2089x1764px:
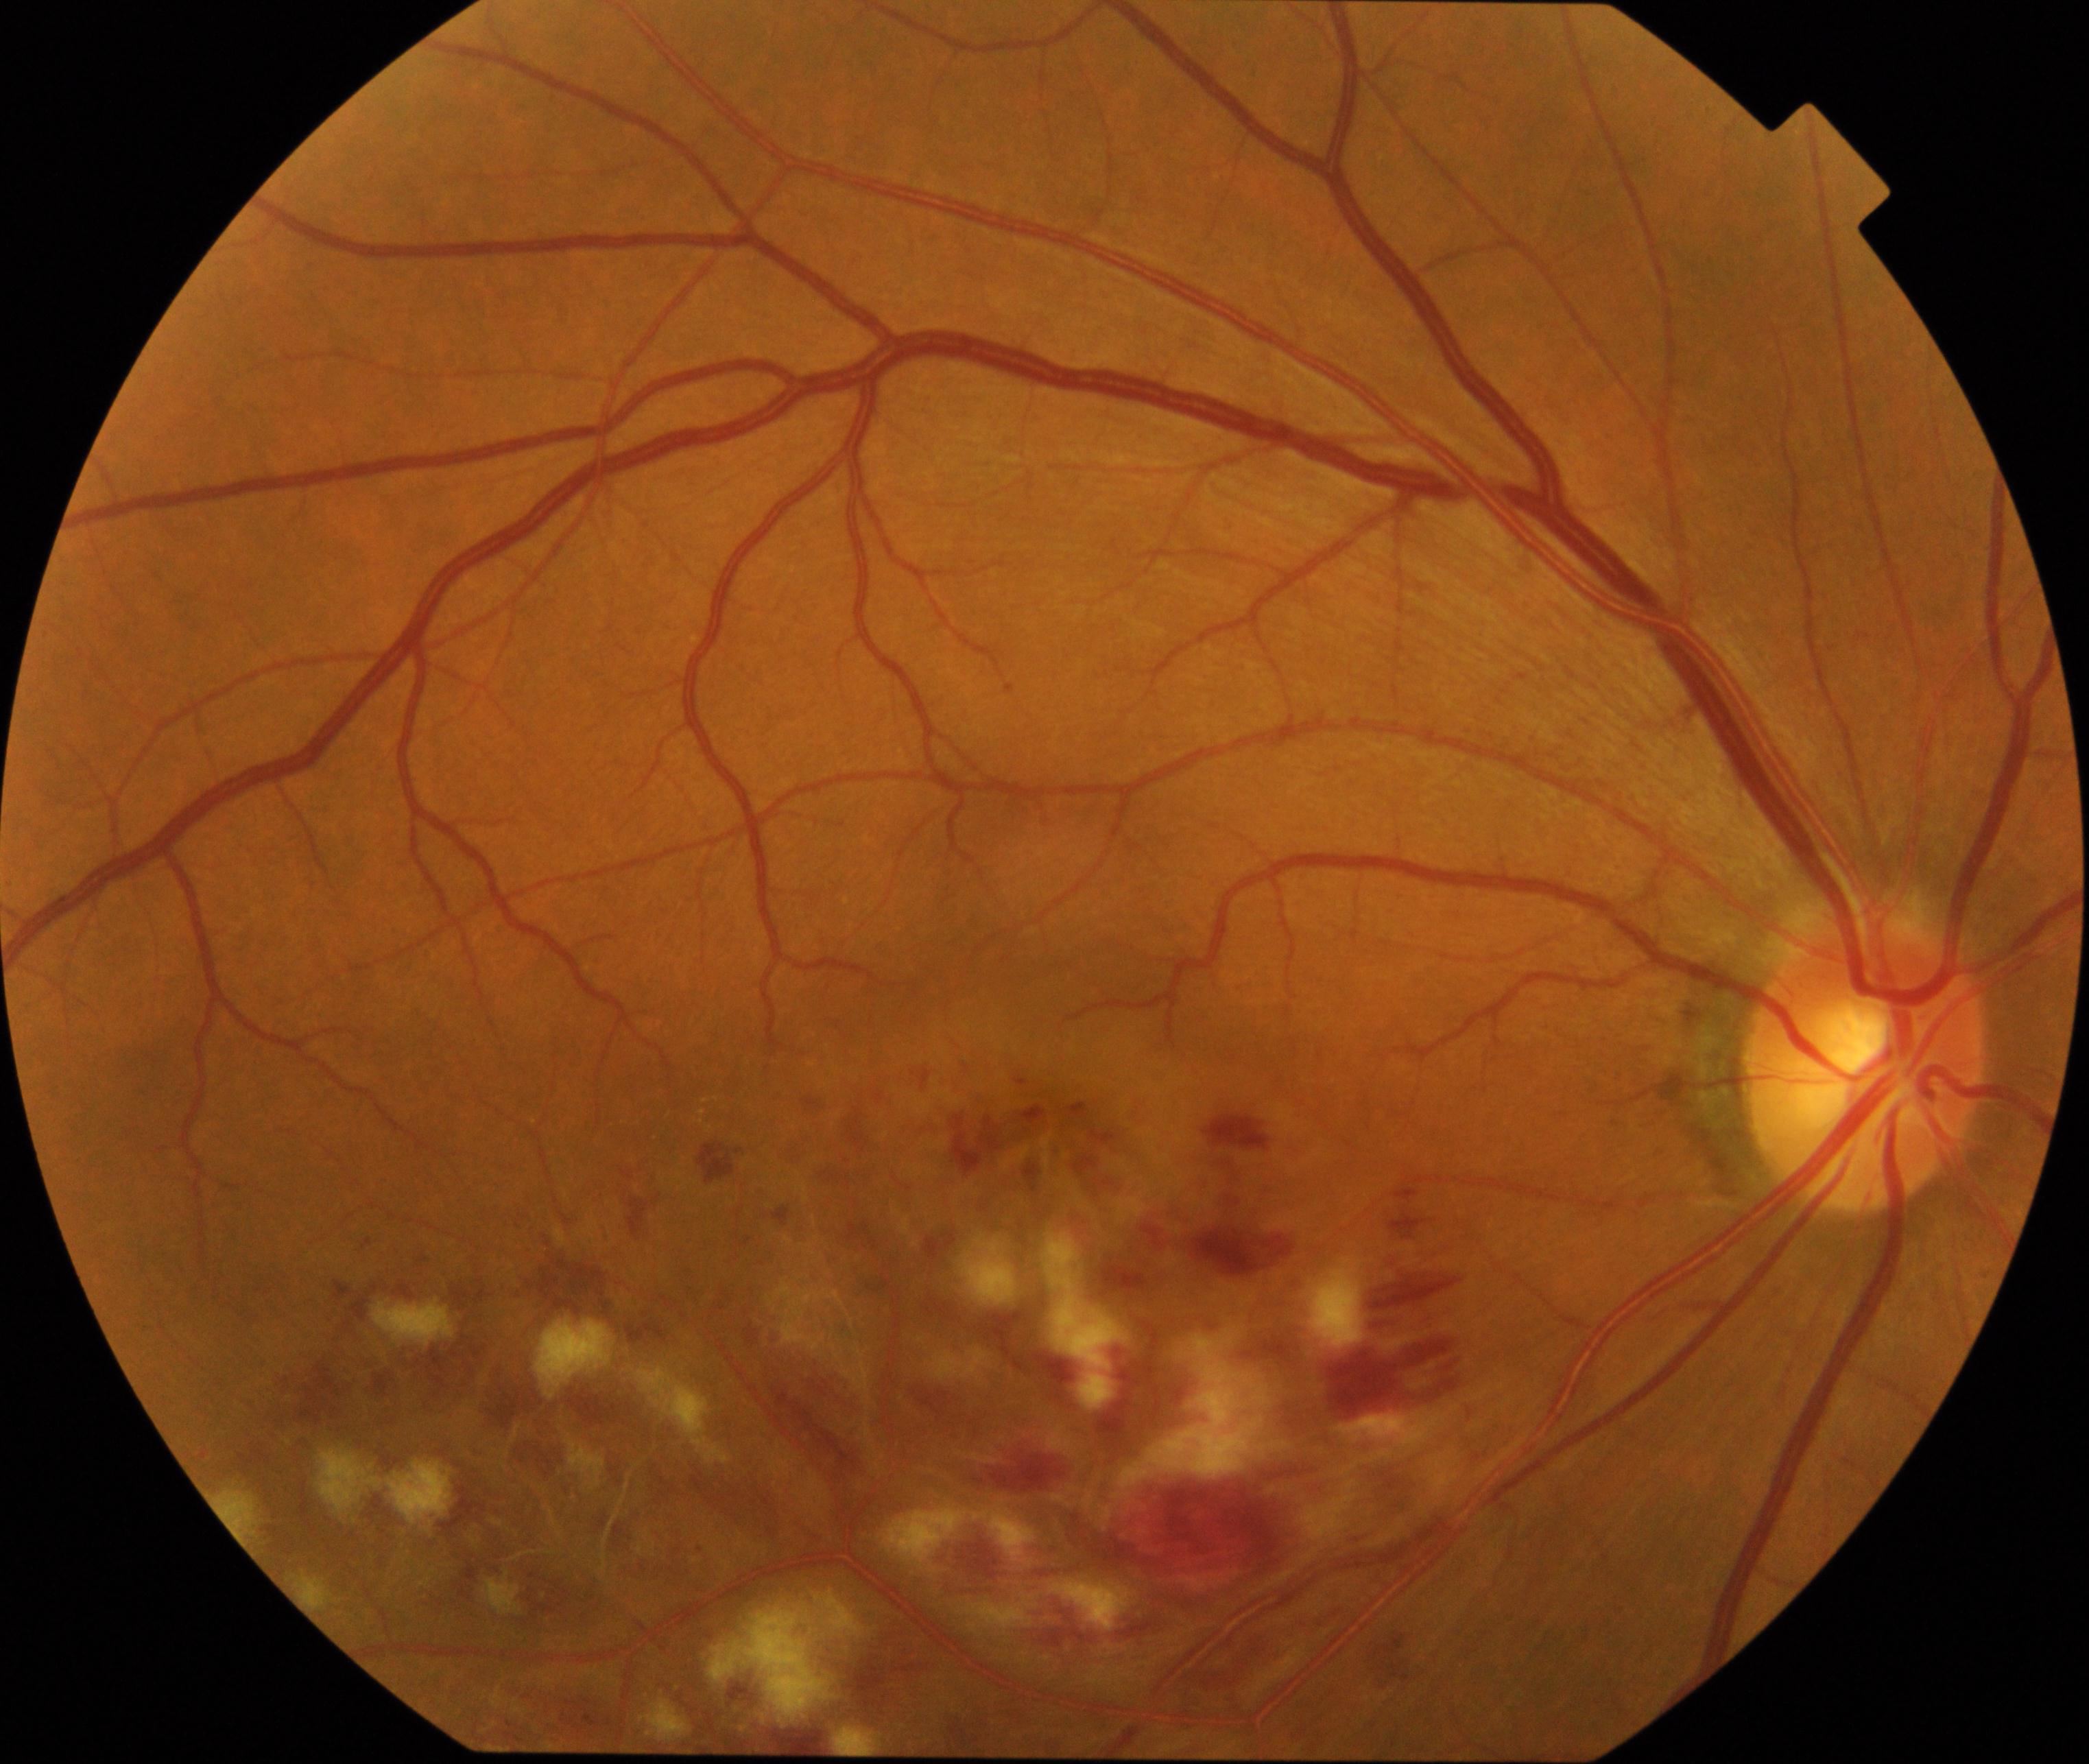 Primary finding: branch retinal vein occlusion.